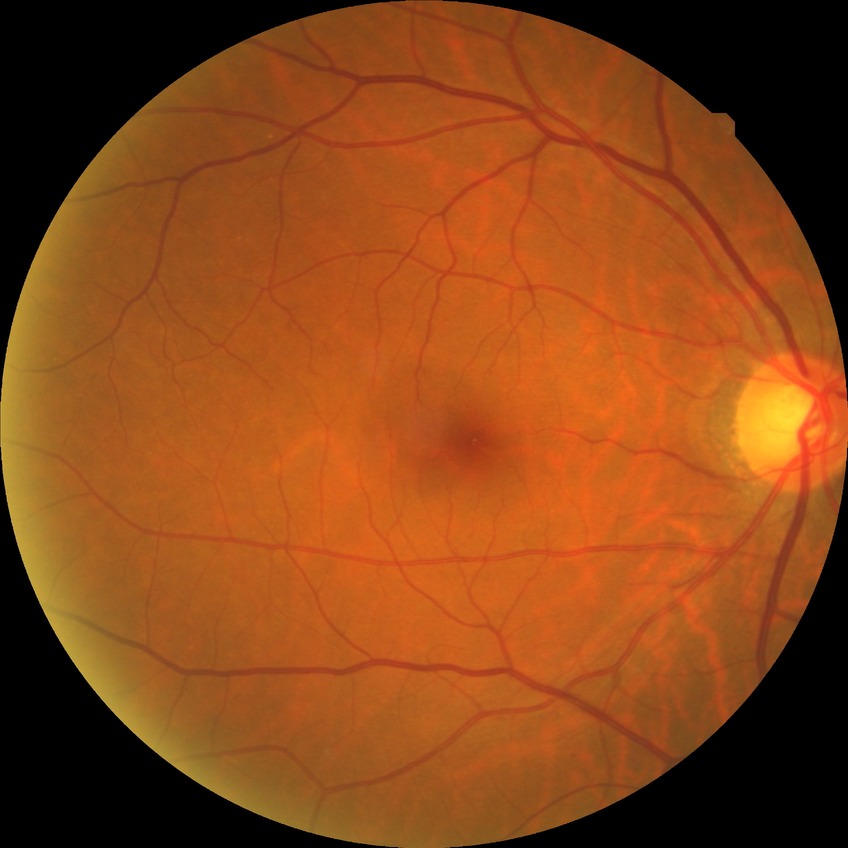 modified Davis grading = simple diabetic retinopathy
DR class = non-proliferative diabetic retinopathy